45° FOV. Posterior pole color fundus photograph. NIDEK AFC-230. 848x848px: 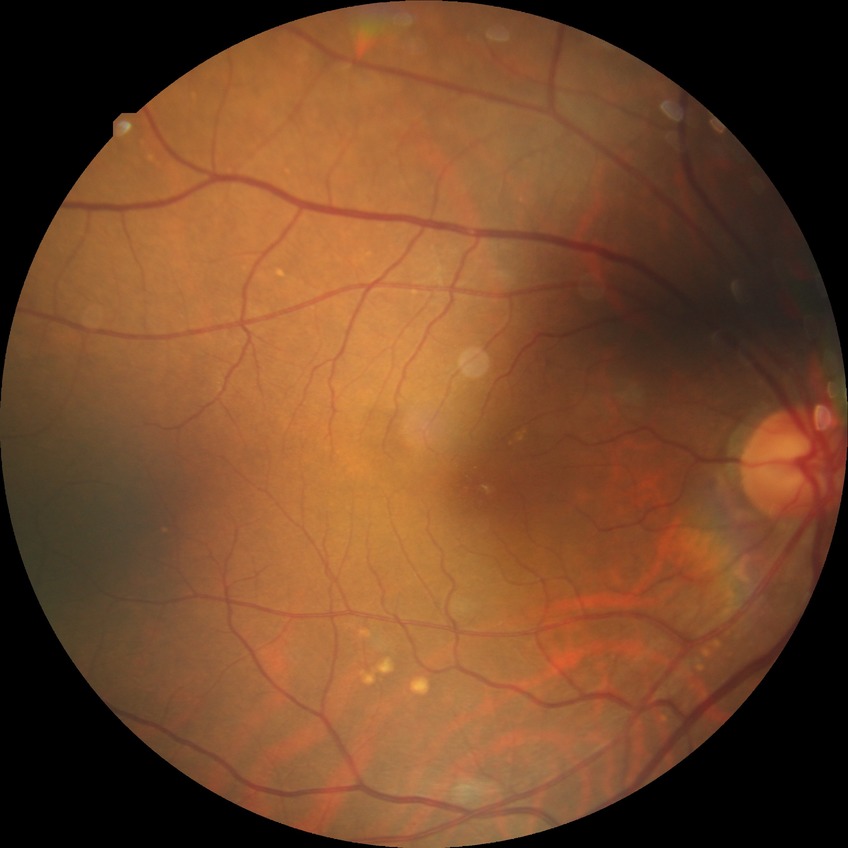
davis_grade: no diabetic retinopathy (NDR)